848x848. Without pupil dilation. Acquired with a NIDEK AFC-230 — 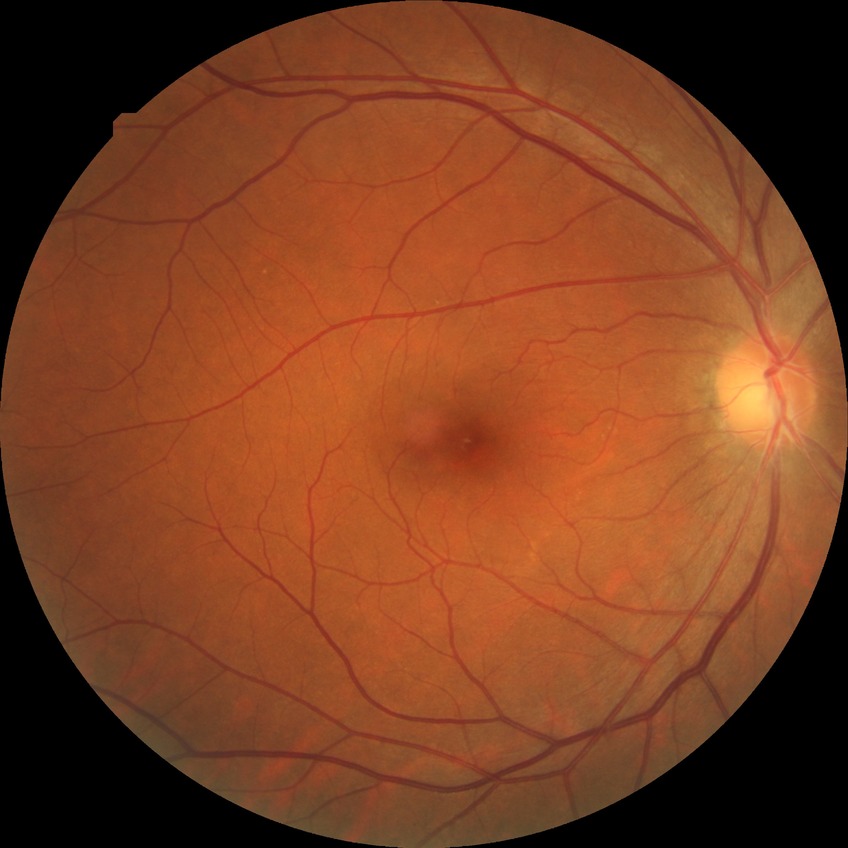

DR severity: NDR. No diabetic retinal disease findings.